45° FOV
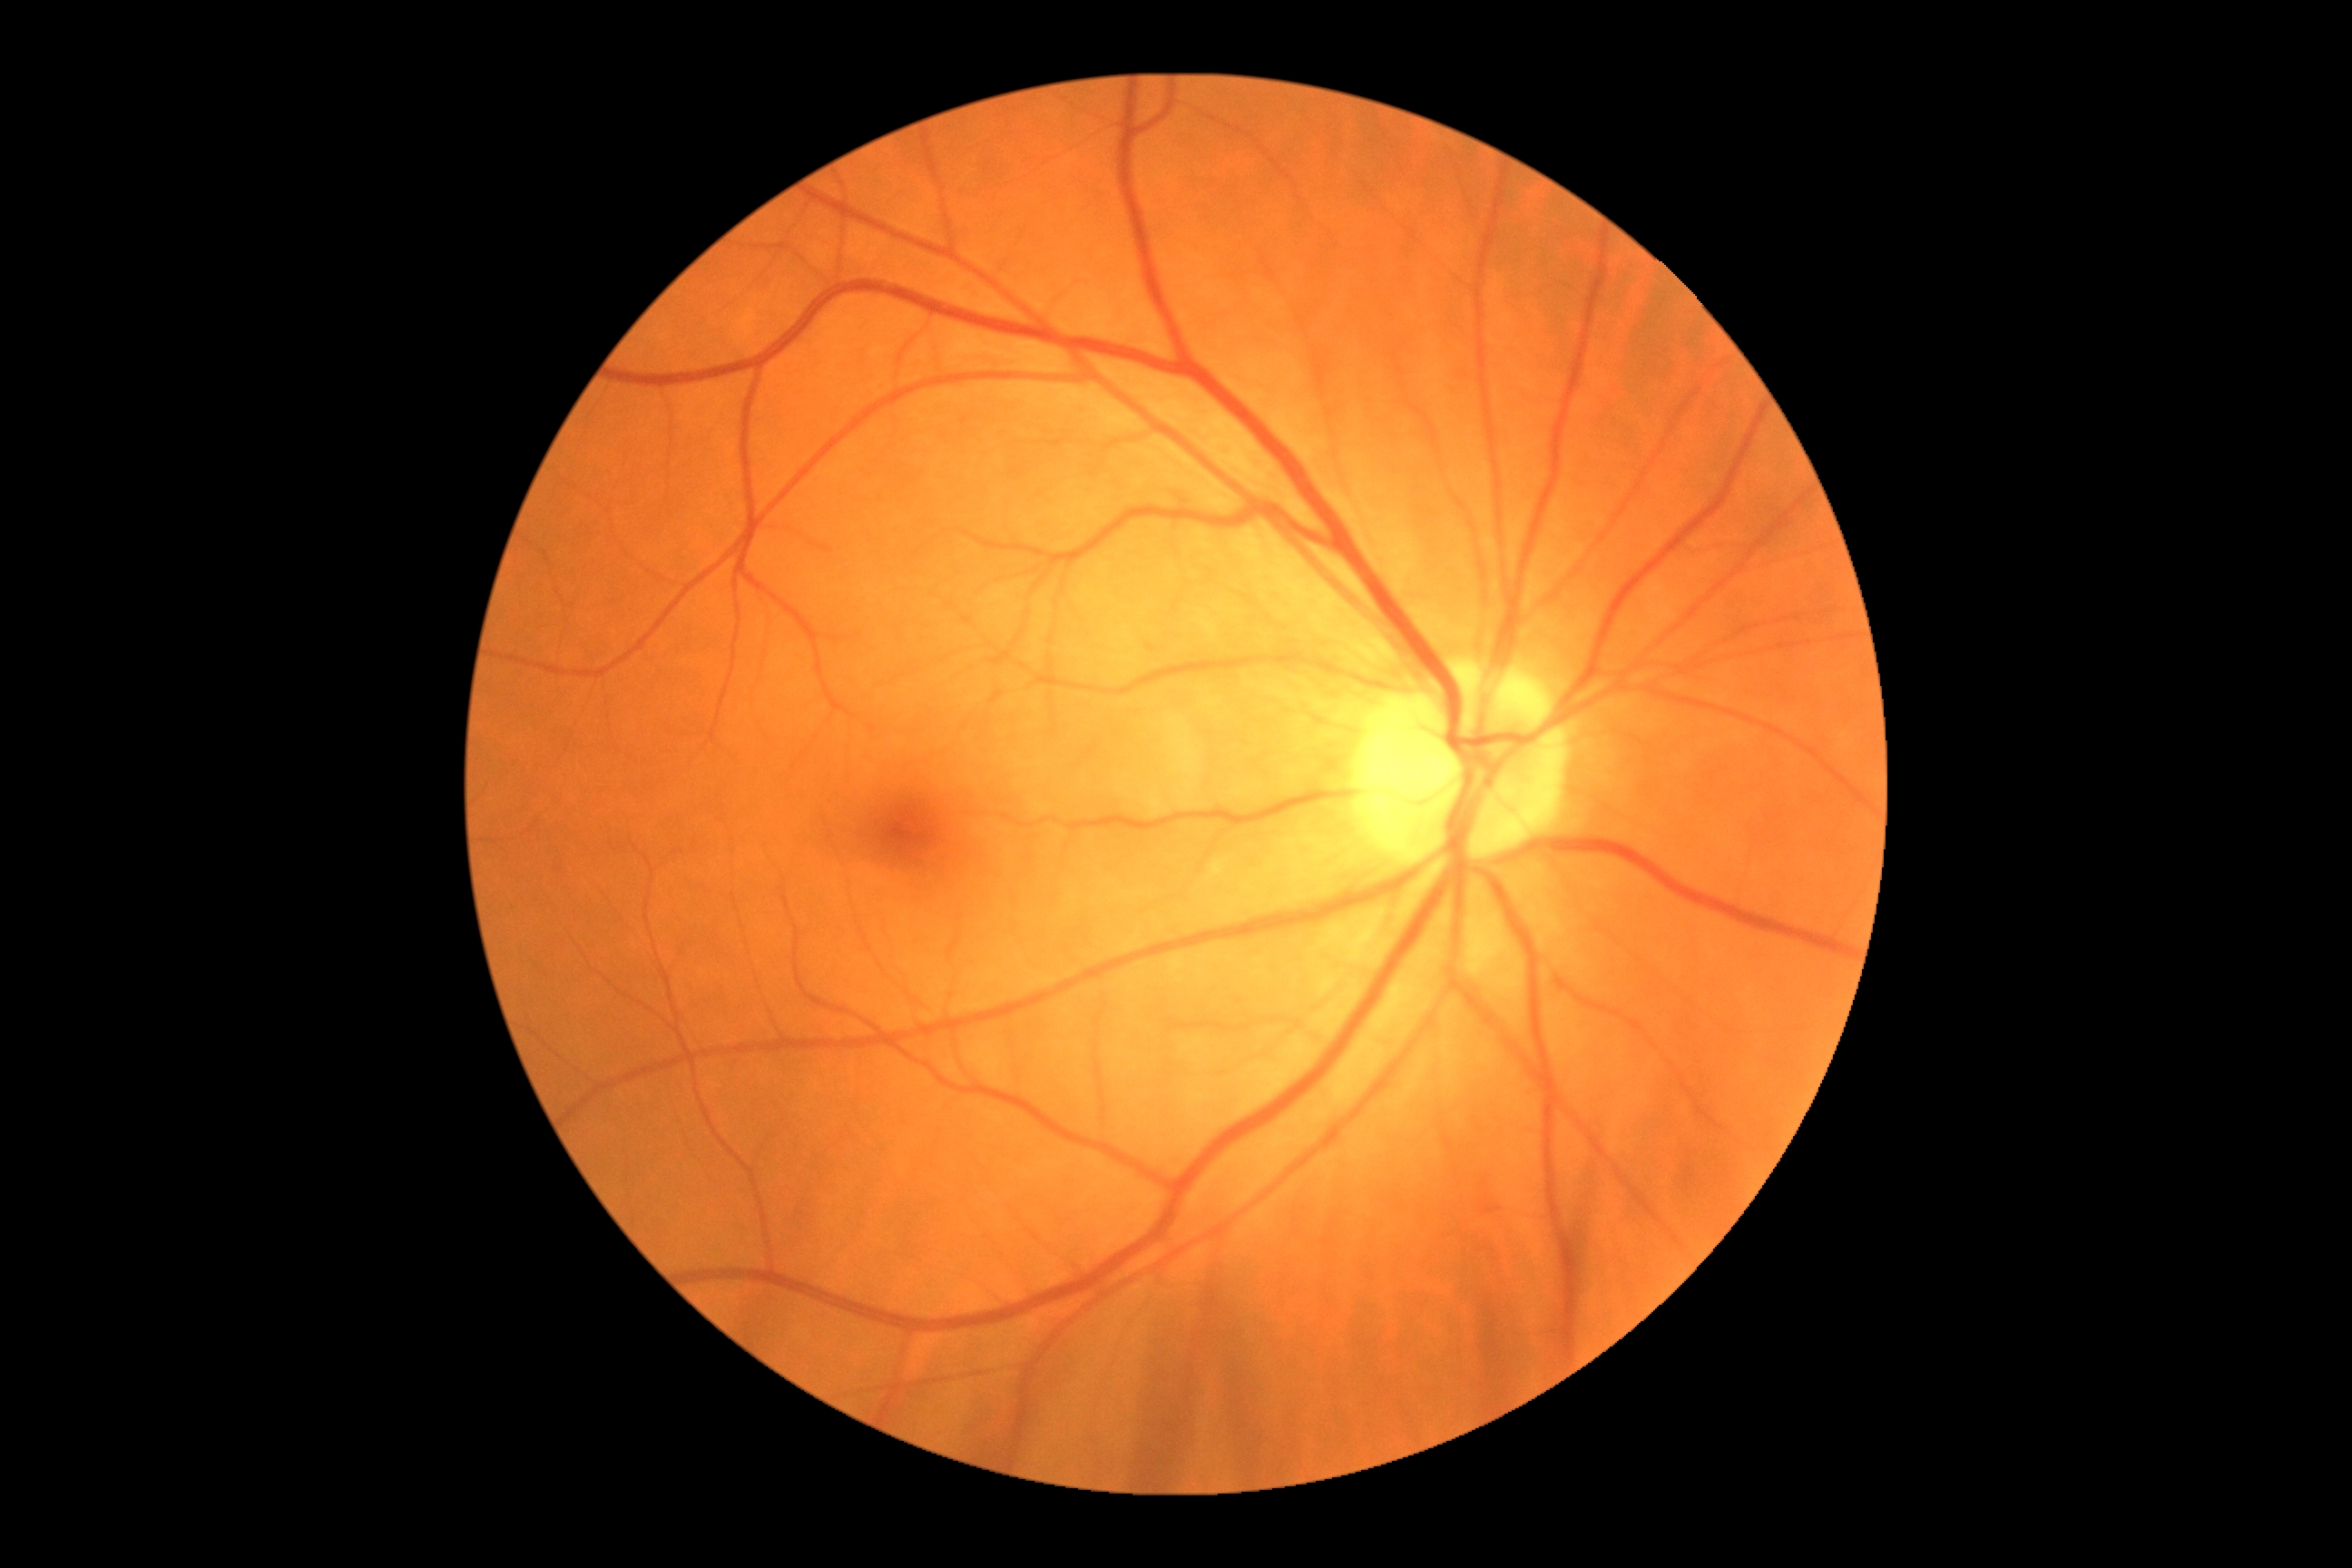 Diabetic retinopathy is 0/4.